Diabetic retinopathy graded by the modified Davis classification.
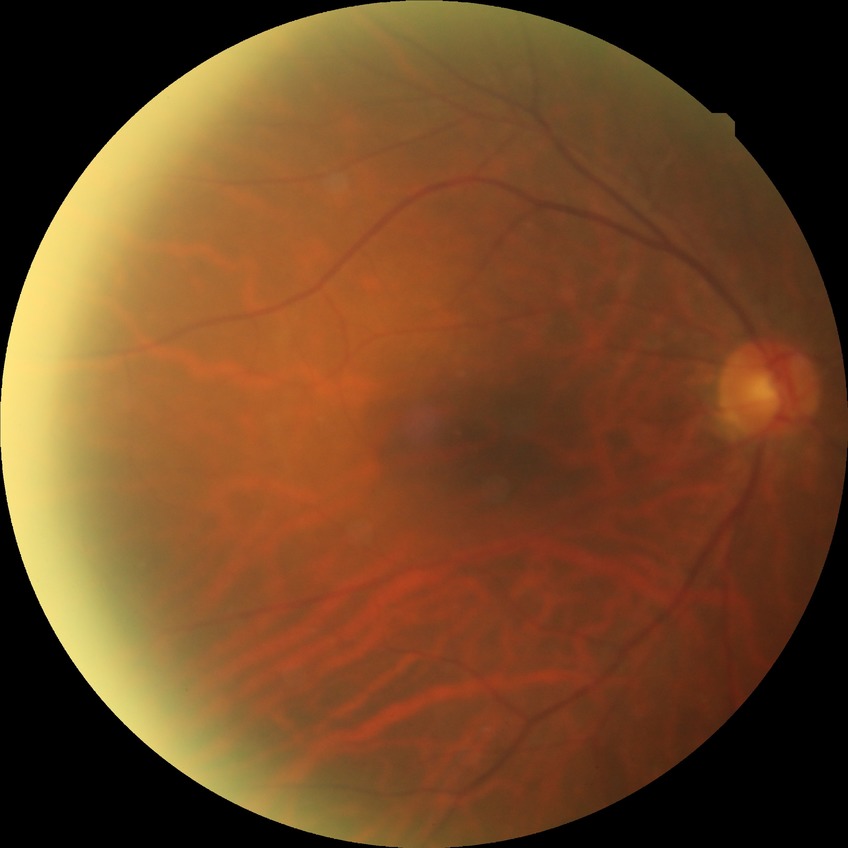

Diabetic retinopathy (DR) is NDR (no diabetic retinopathy).